1659x2212px. Captured on a Remidio Fundus on Phone — 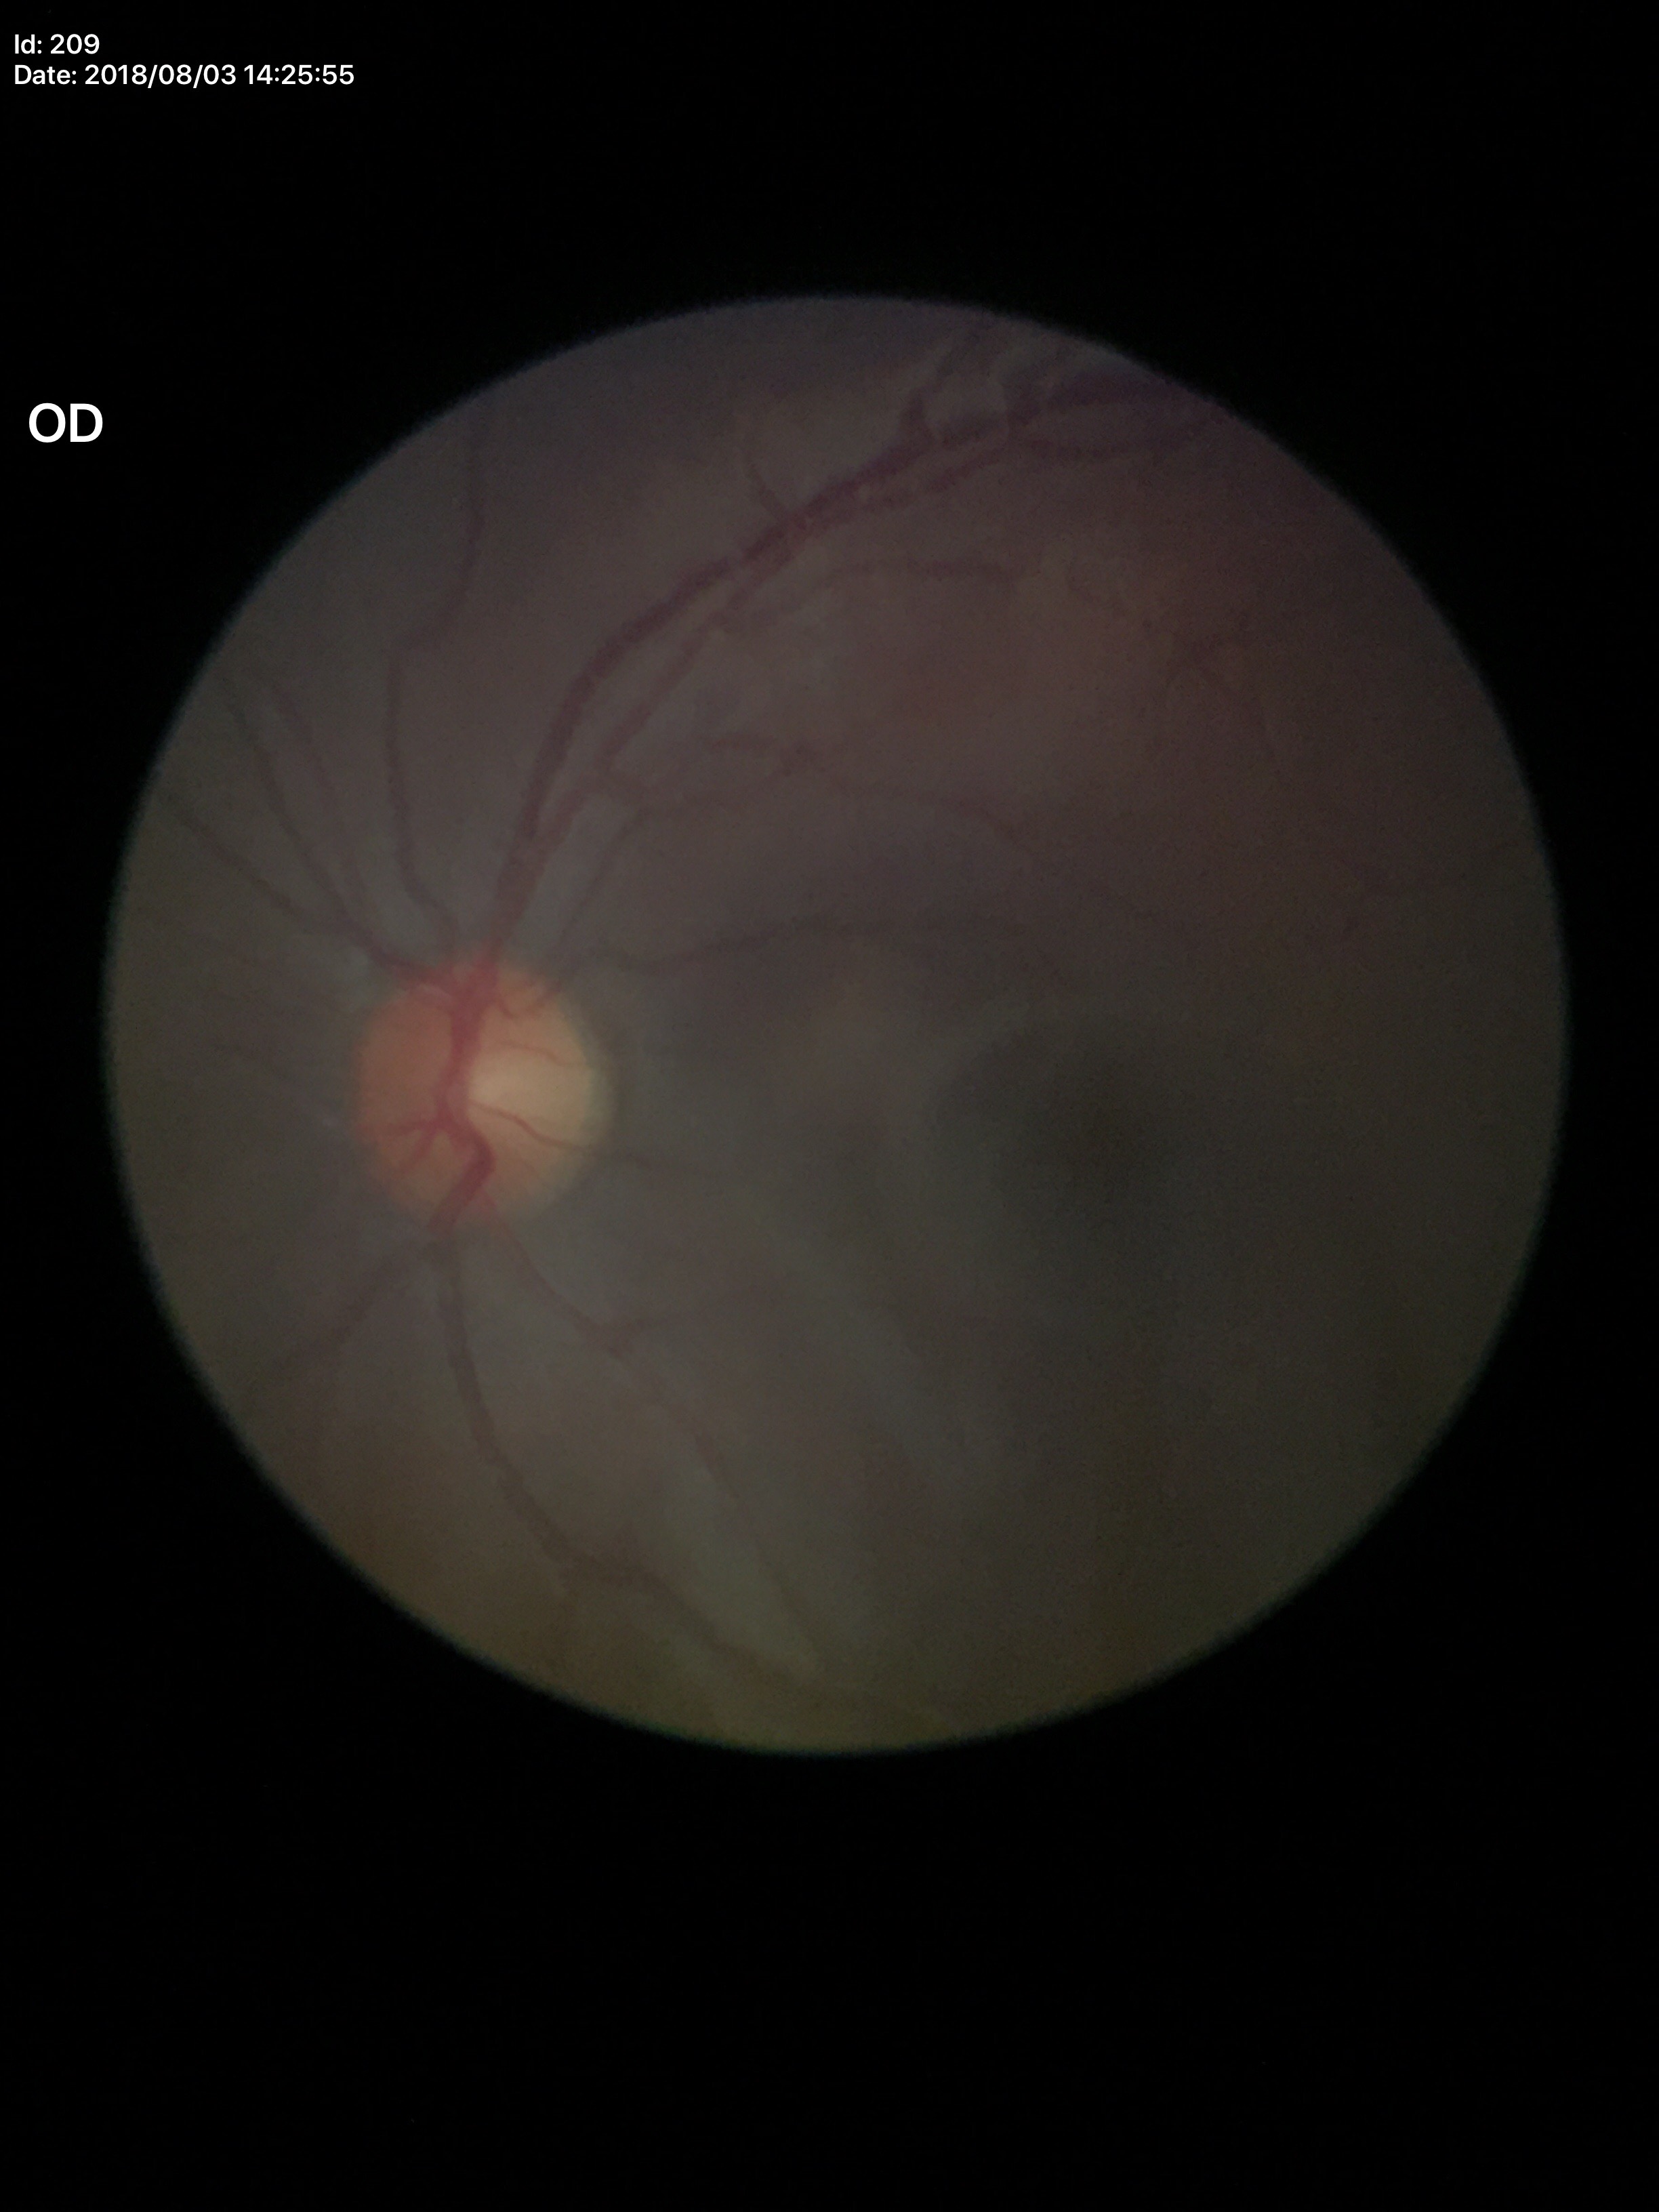 Horizontal cup-disc ratio (HCDR) of 0.40. Glaucoma impression: not suspect. Vertical CDR (VCDR) of 0.41.